Color fundus image
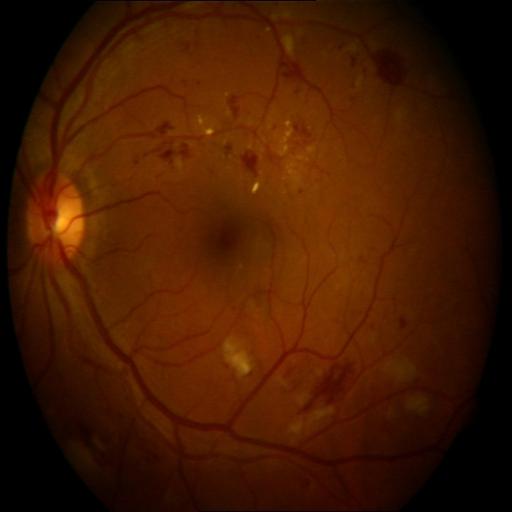 There is evidence of hemorrhagic retinopathy and exudation.